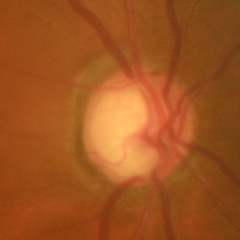
Q: What stage of glaucoma is present?
A: Yes — early glaucoma.